Nonmydriatic; NIDEK AFC-230 fundus camera; Davis DR grading; 848x848.
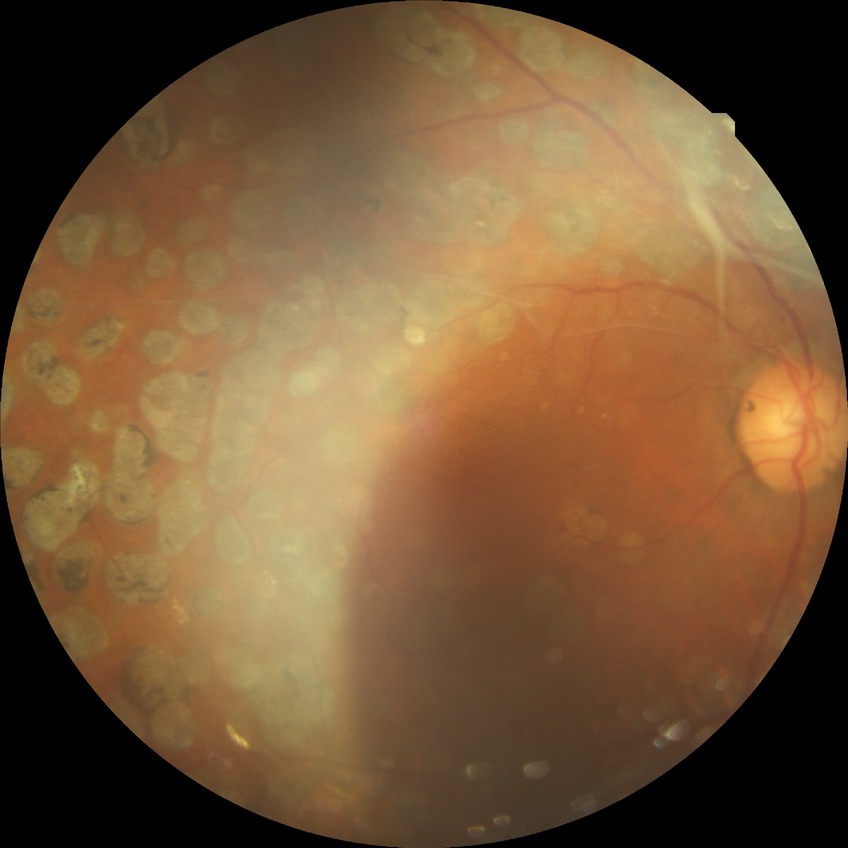

Diabetic retinopathy (DR) is proliferative diabetic retinopathy (PDR).